848 x 848 pixels:
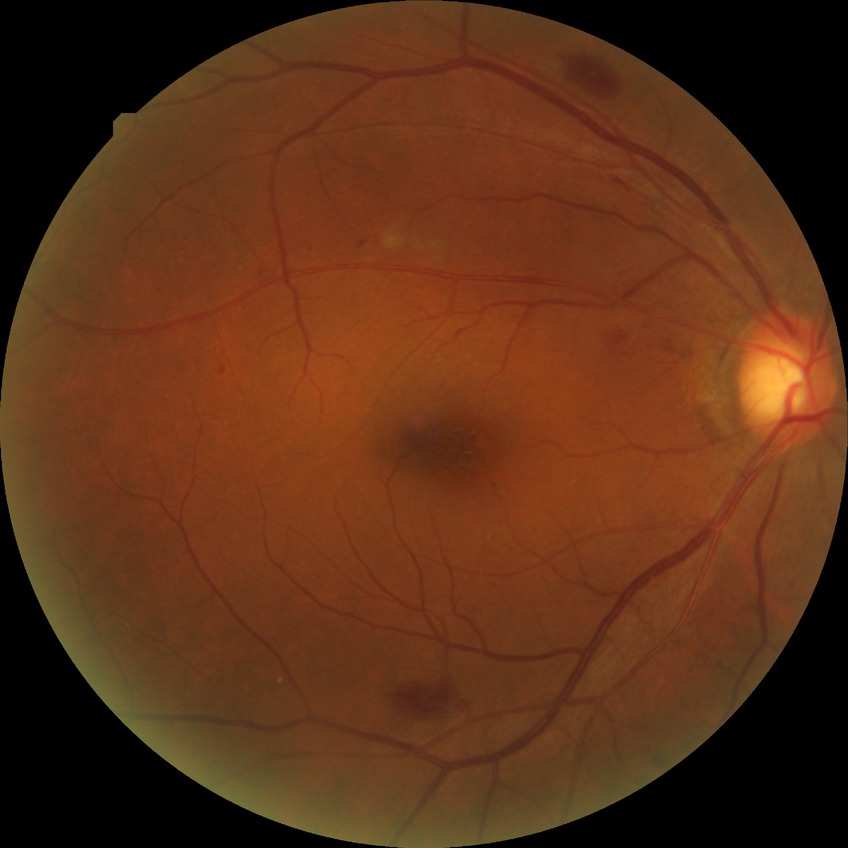
Diabetic retinopathy (DR) is simple diabetic retinopathy (SDR).